45° FOV. NIDEK AFC-230. DR severity per modified Davis staging:
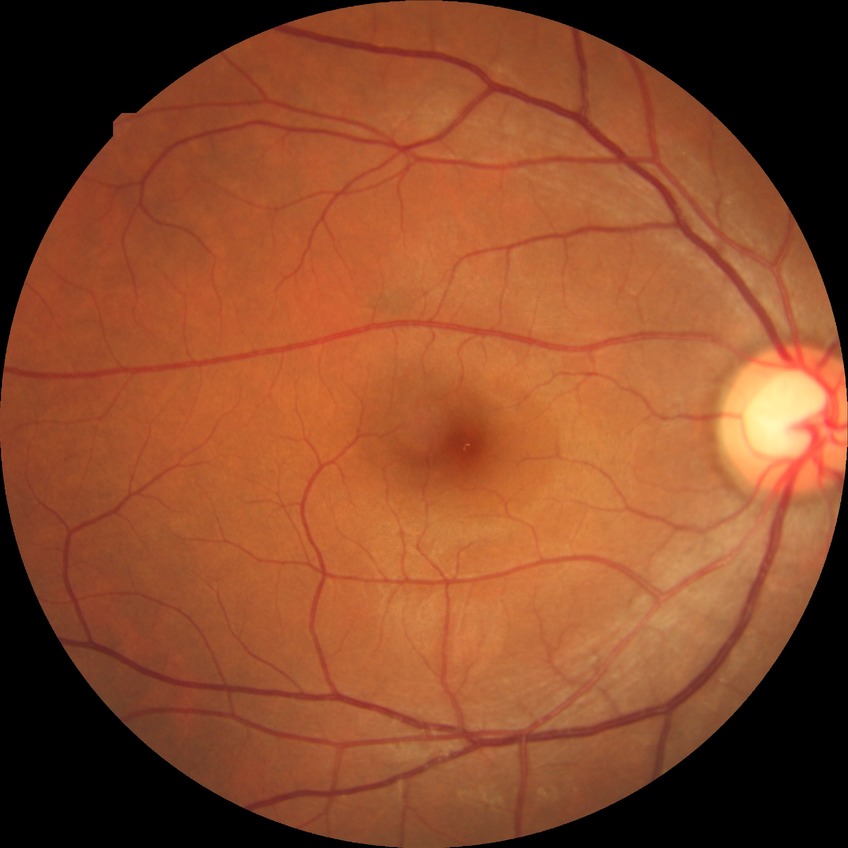

Diabetic retinopathy (DR): NDR (no diabetic retinopathy).